Wide-field contact fundus photograph of an infant.
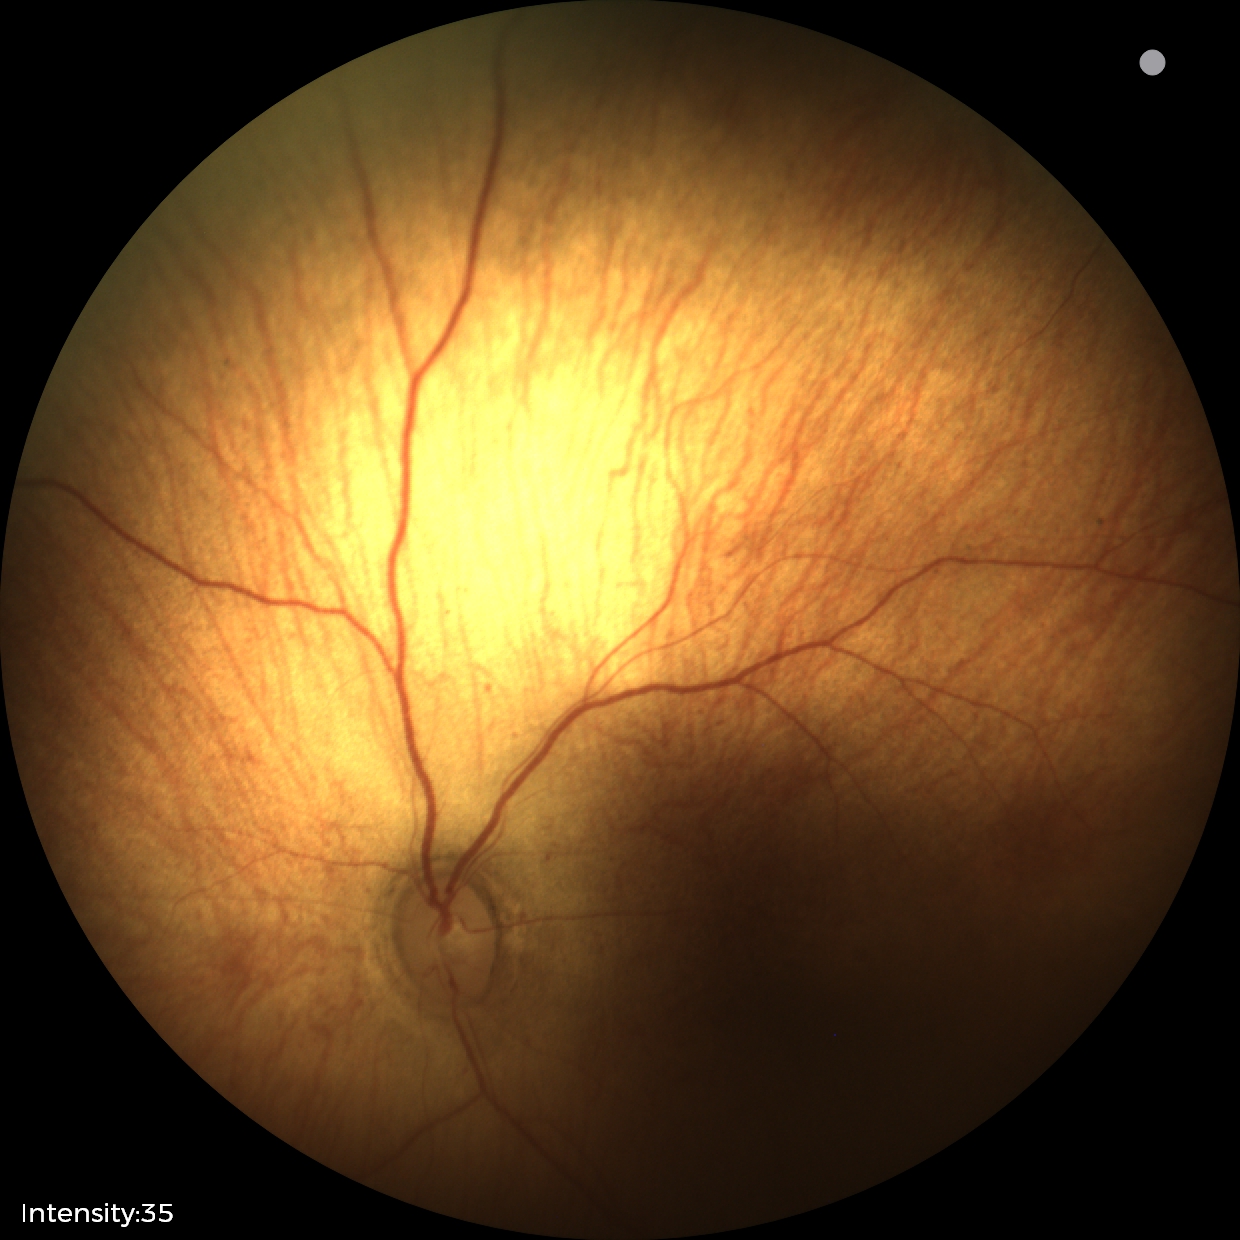
Diagnosis from this screening exam: status post ROP.